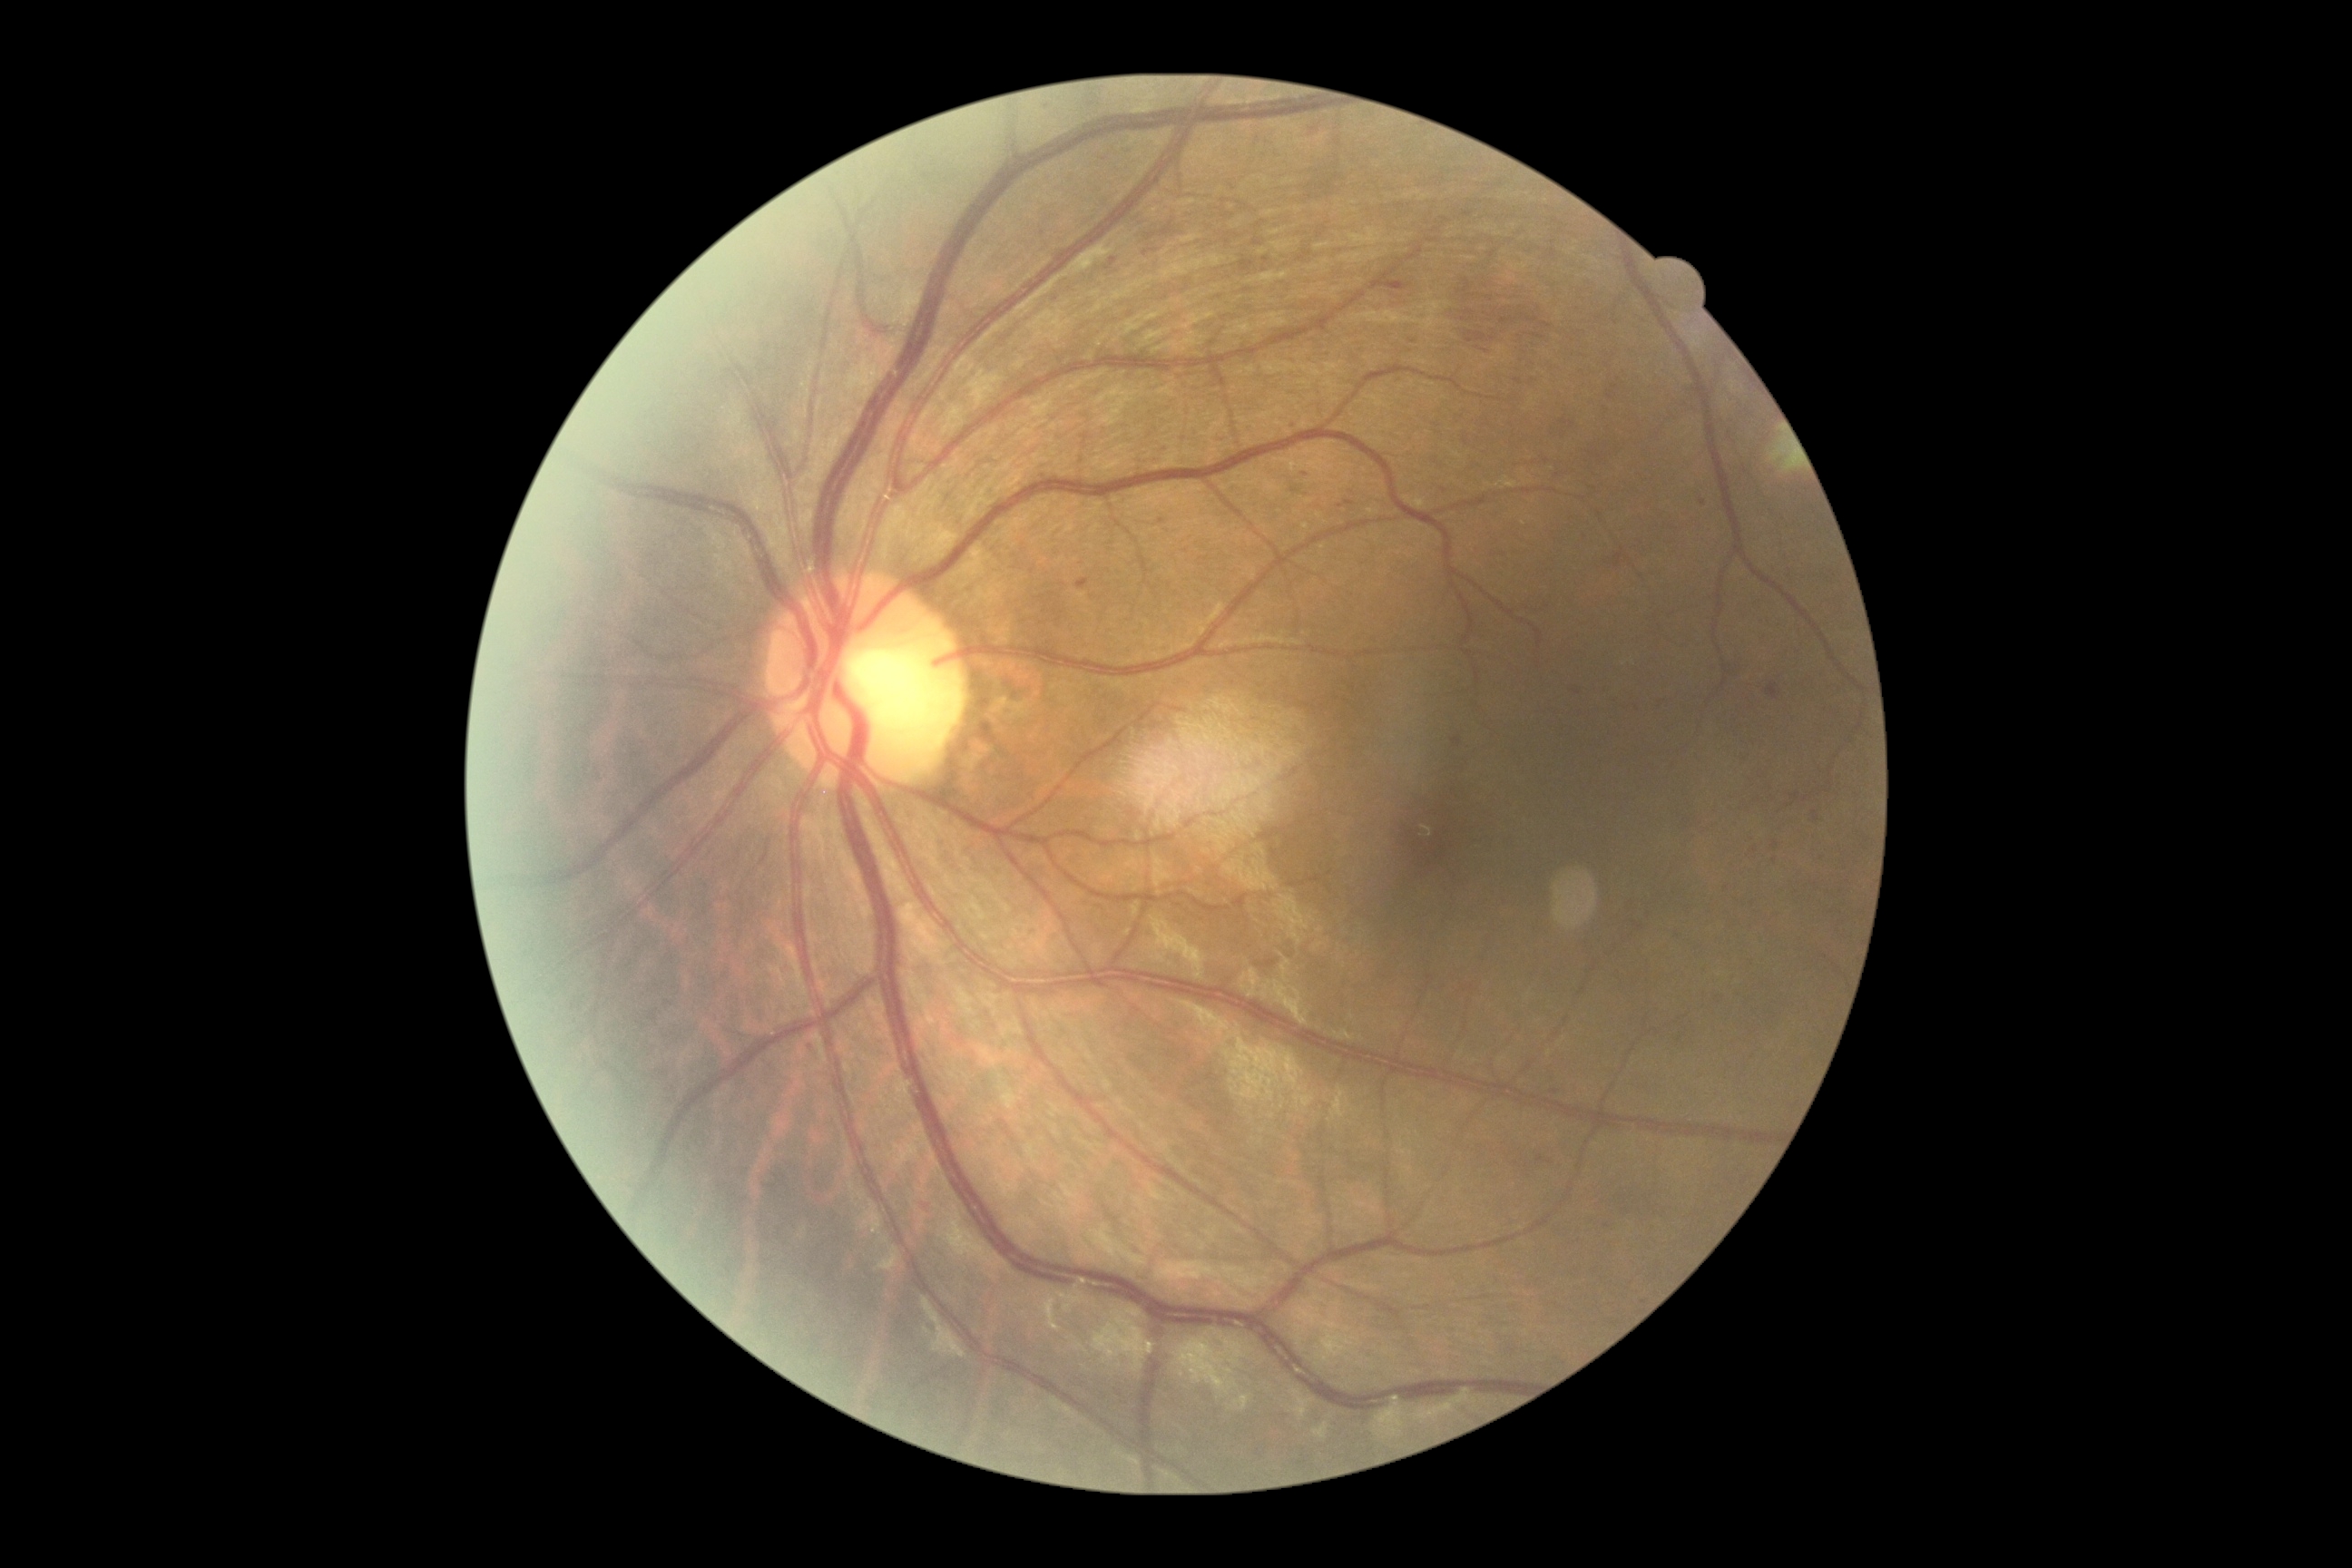
Diabetic retinopathy (DR): moderate NPDR (grade 2).